No pharmacologic dilation; color fundus image; NIDEK AFC-230 fundus camera; 848x848; 45 degree fundus photograph:
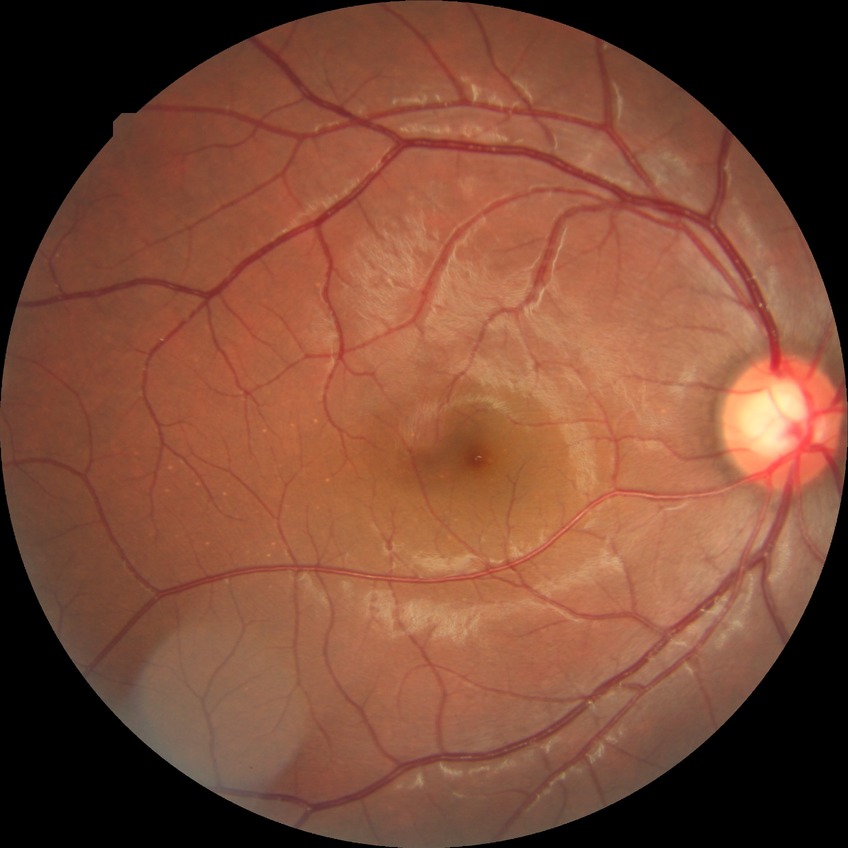
Diabetic retinopathy (DR): NDR (no diabetic retinopathy).